Color fundus image; 2212 by 1659 pixels:
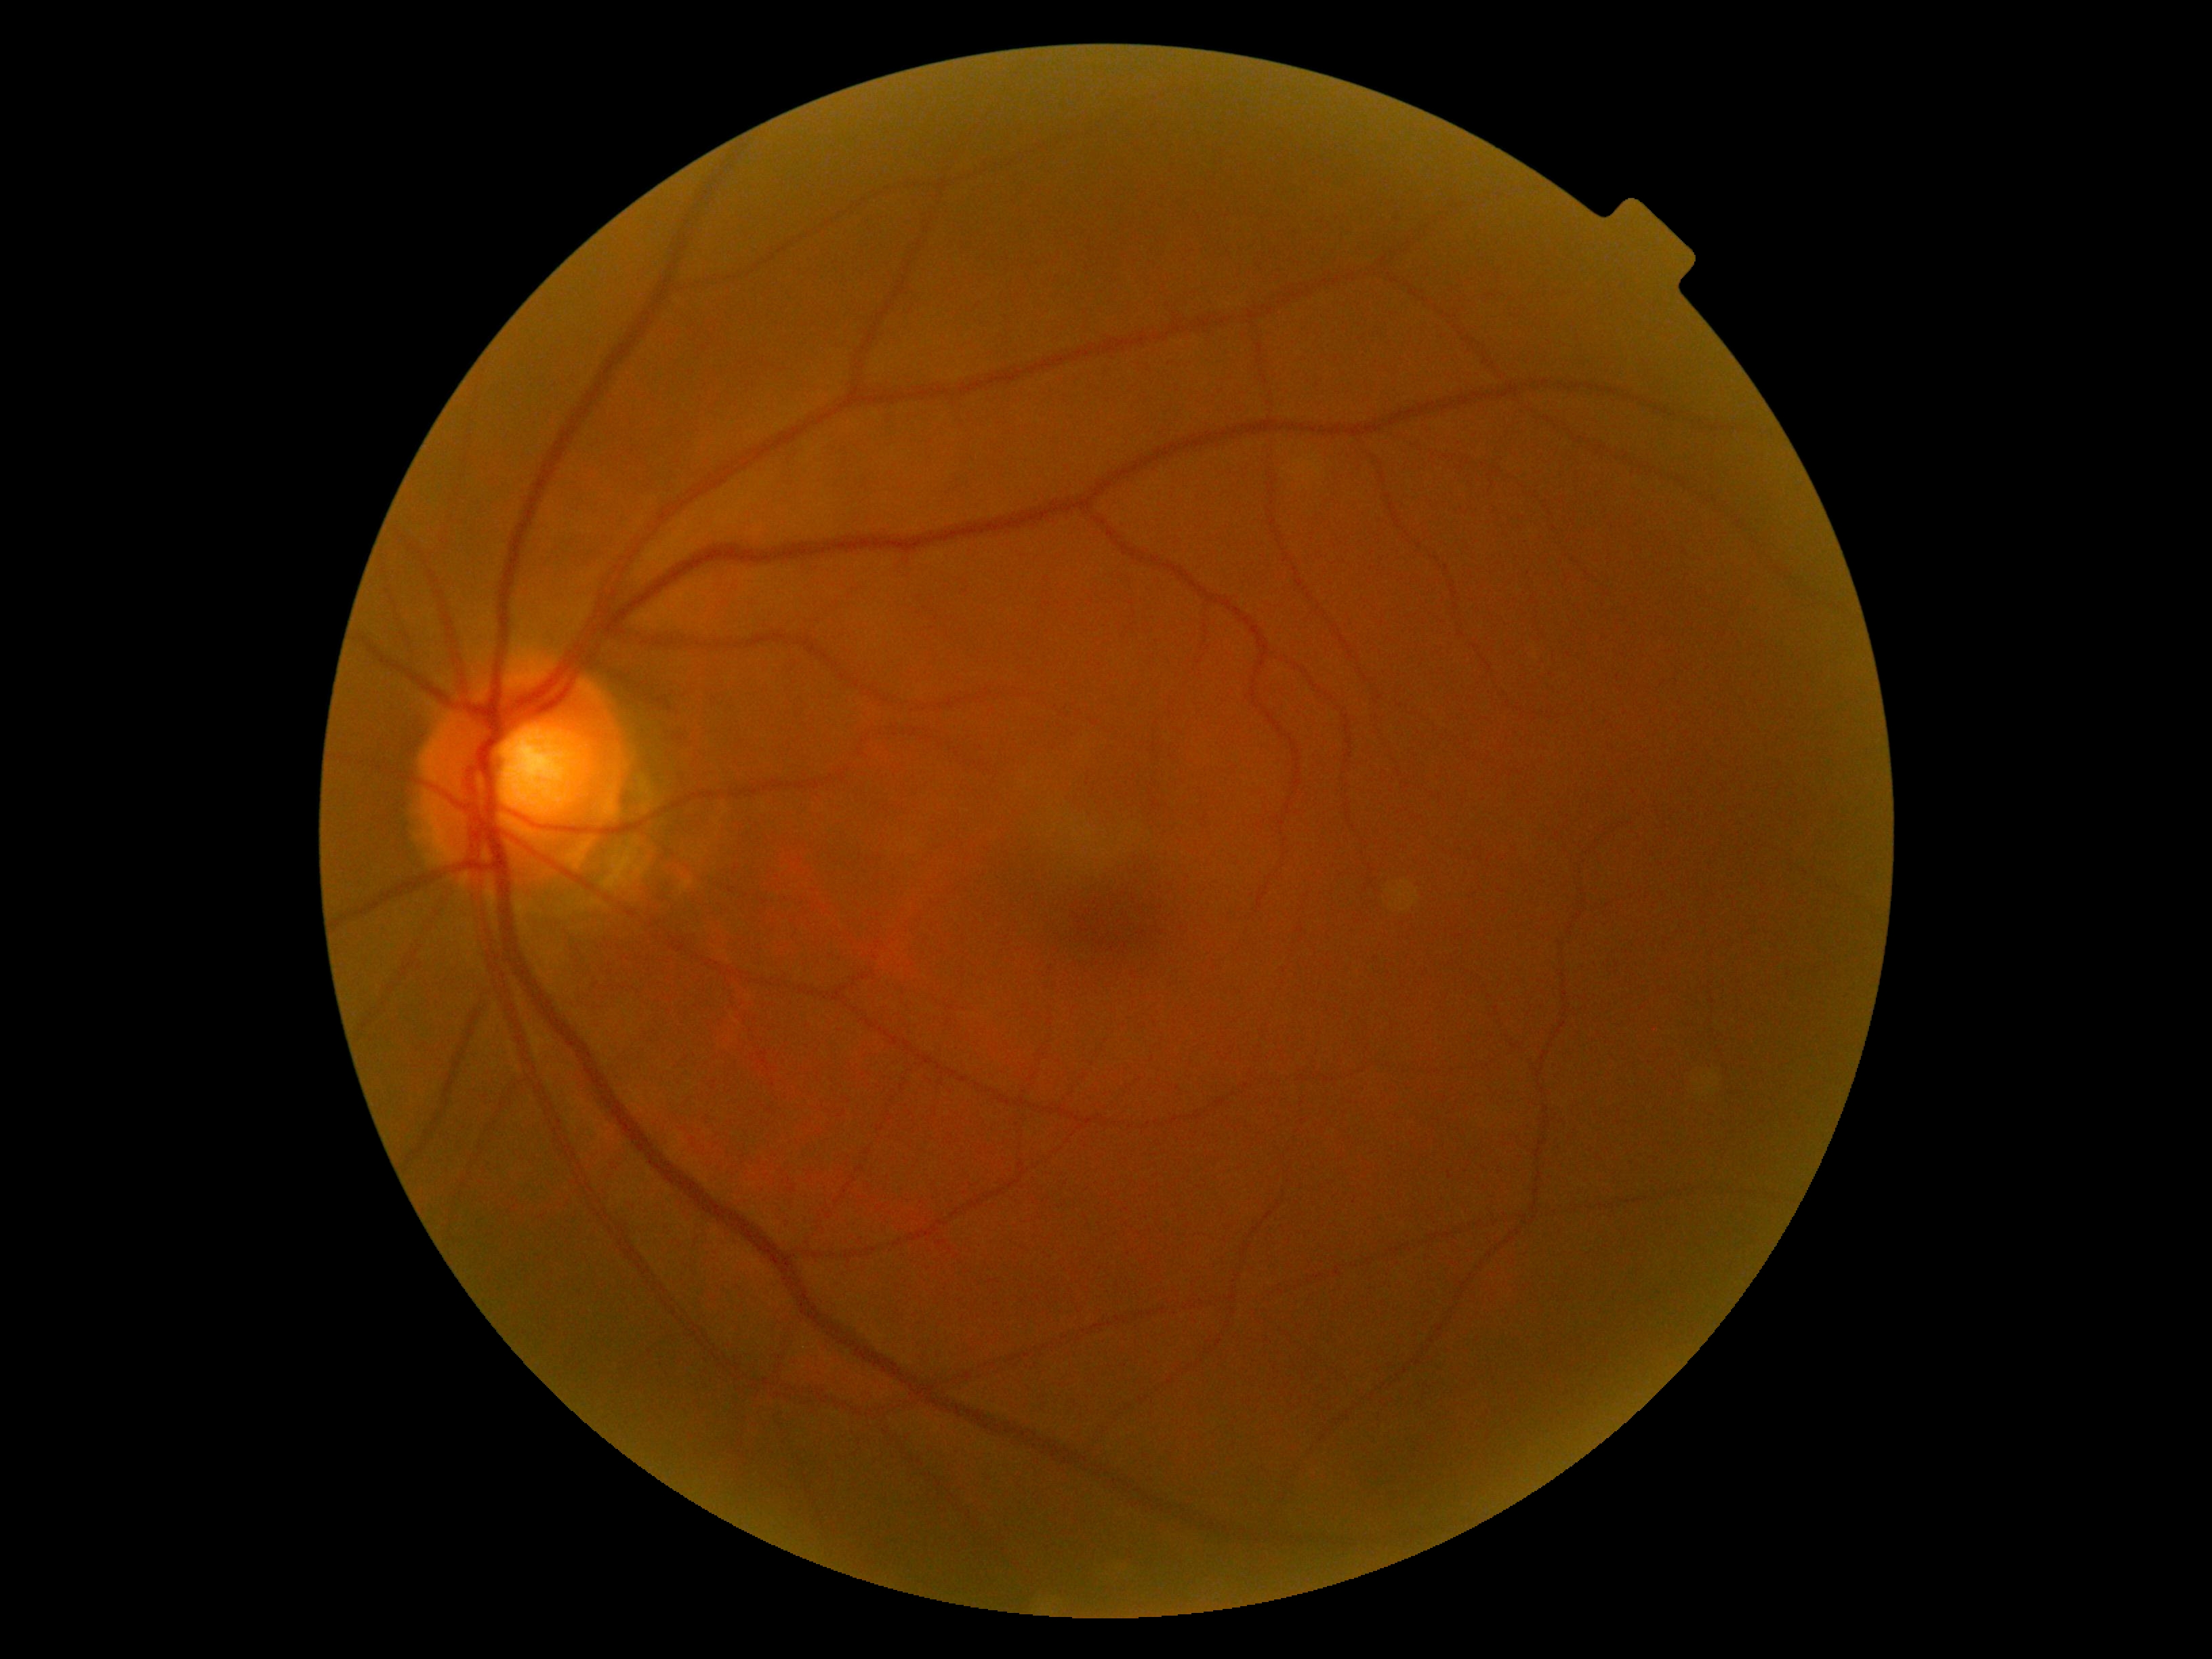

Annotations:
* diabetic retinopathy (DR) — no apparent diabetic retinopathy (grade 0)